2352 x 1568 pixels; retinal fundus photograph; 45° FOV:
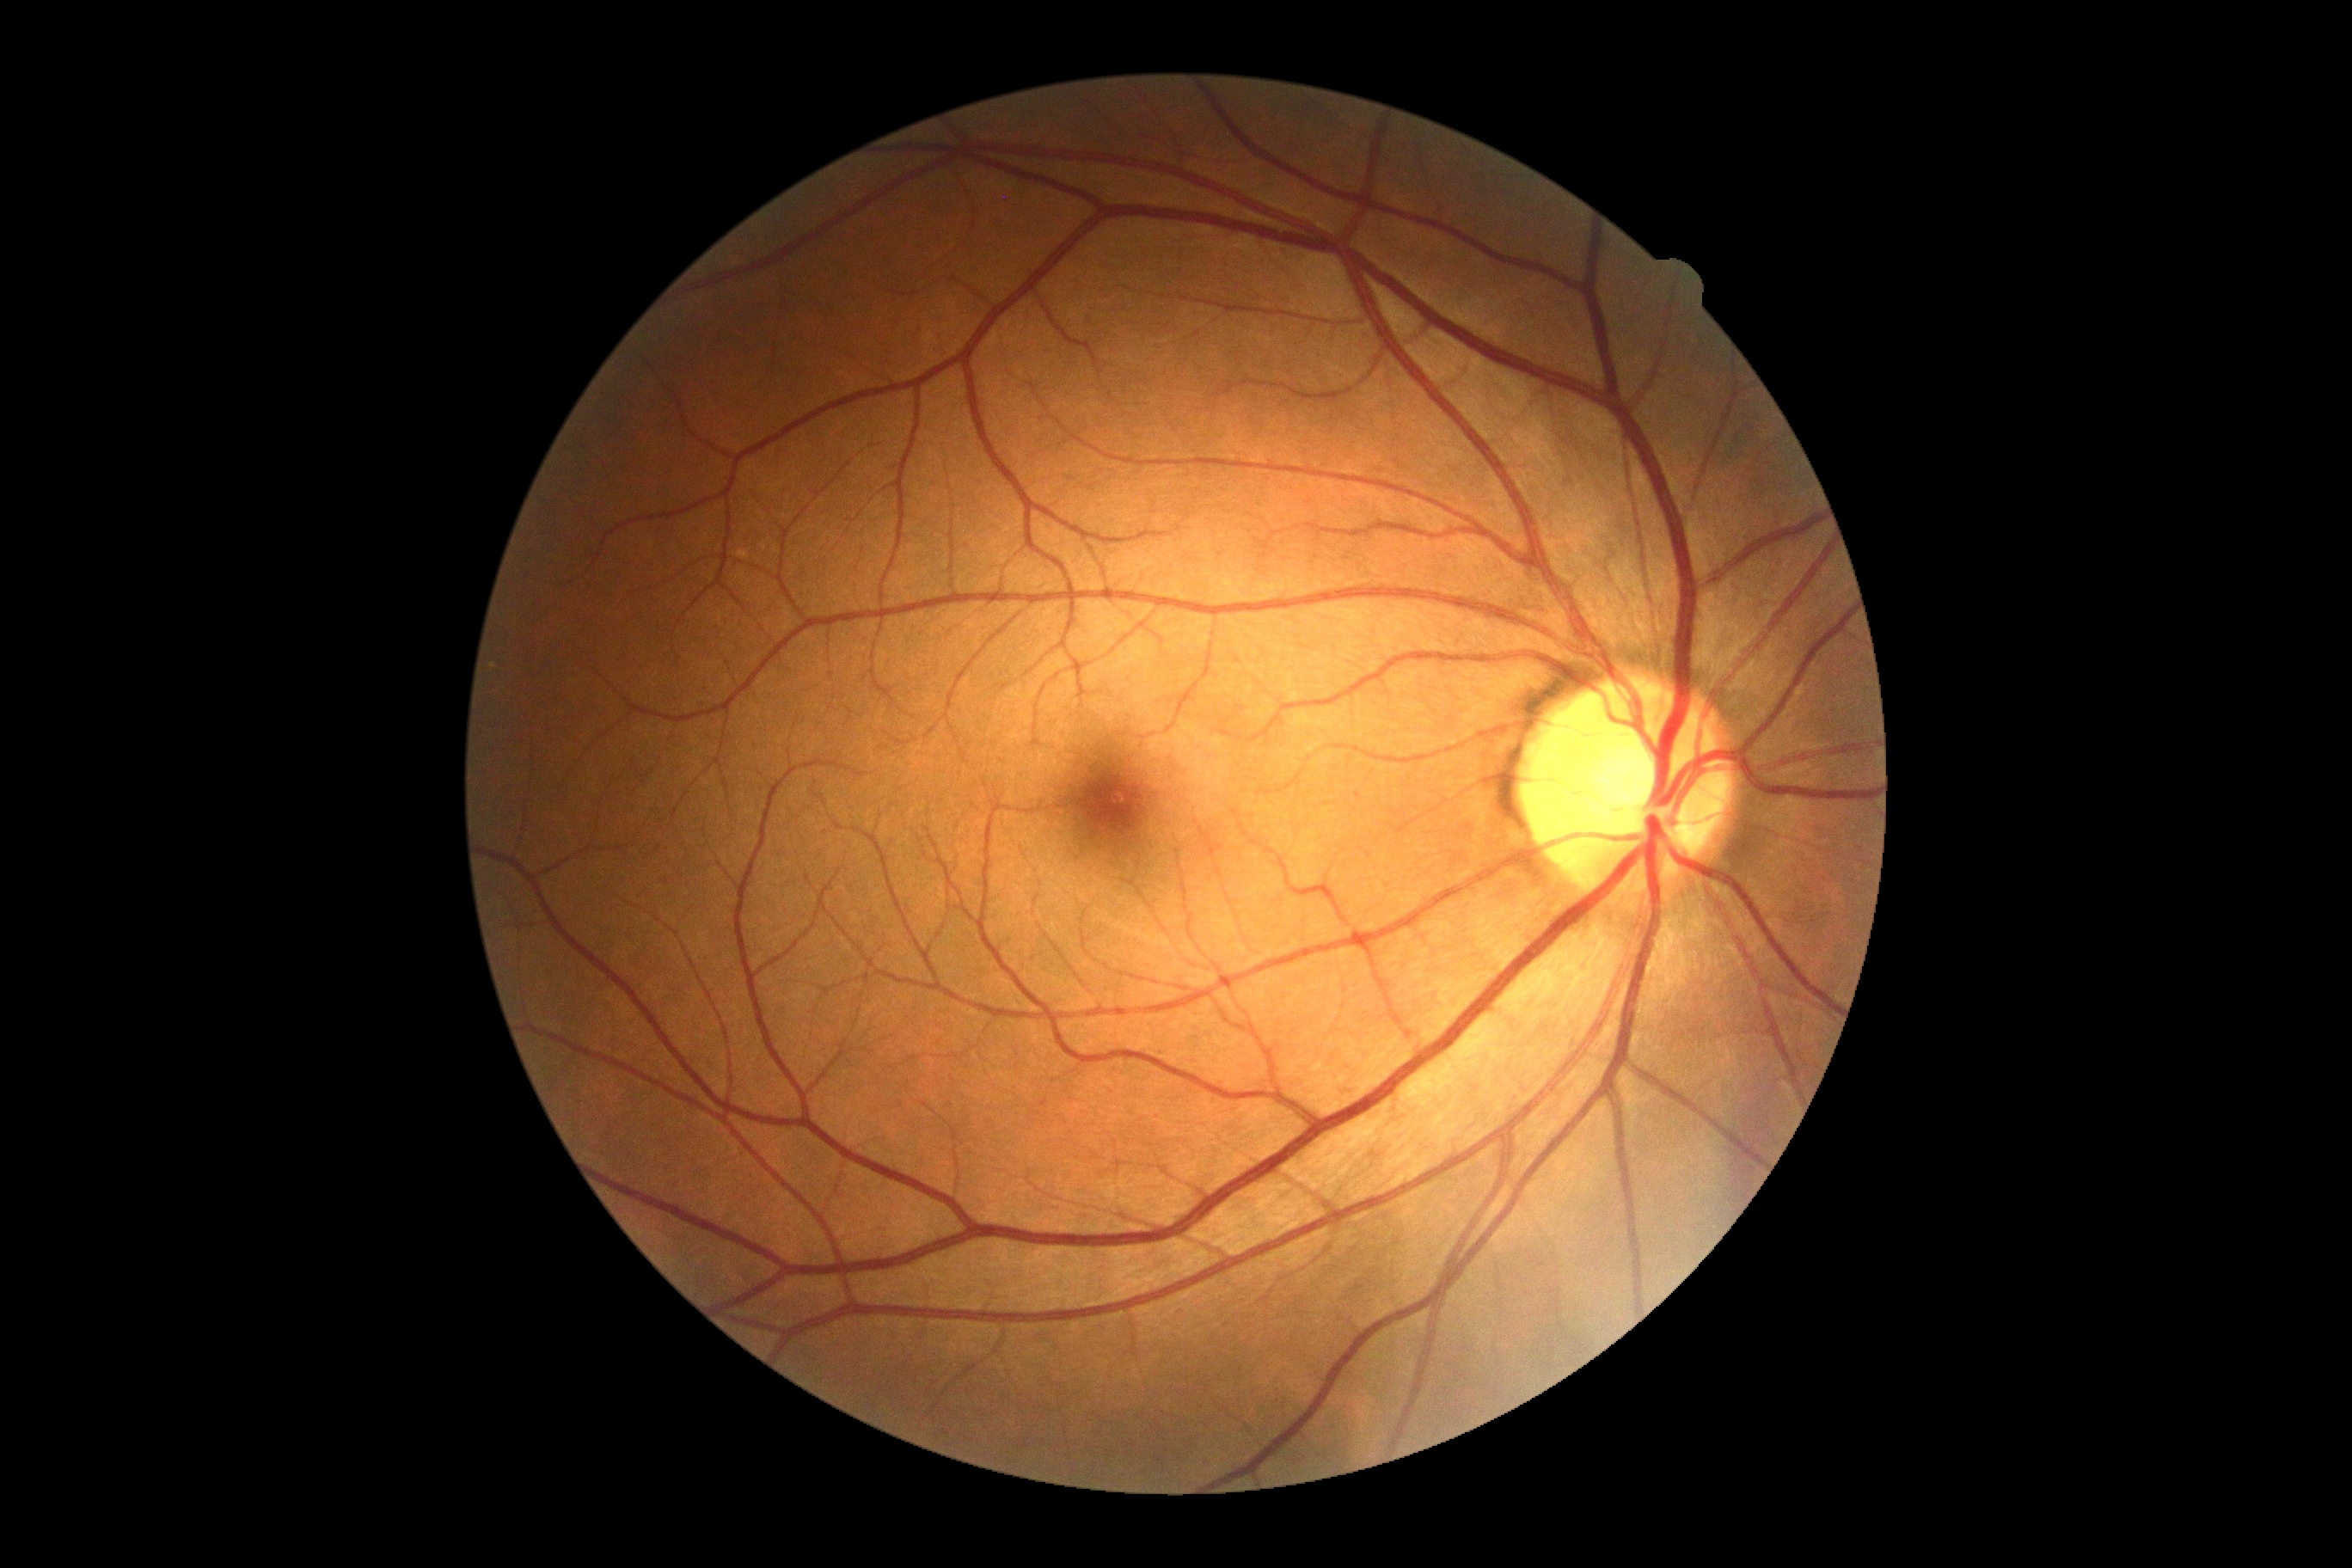 Retinopathy: 0/4 — no visible signs of diabetic retinopathy.